NIDEK AFC-230 · image size 848x848:
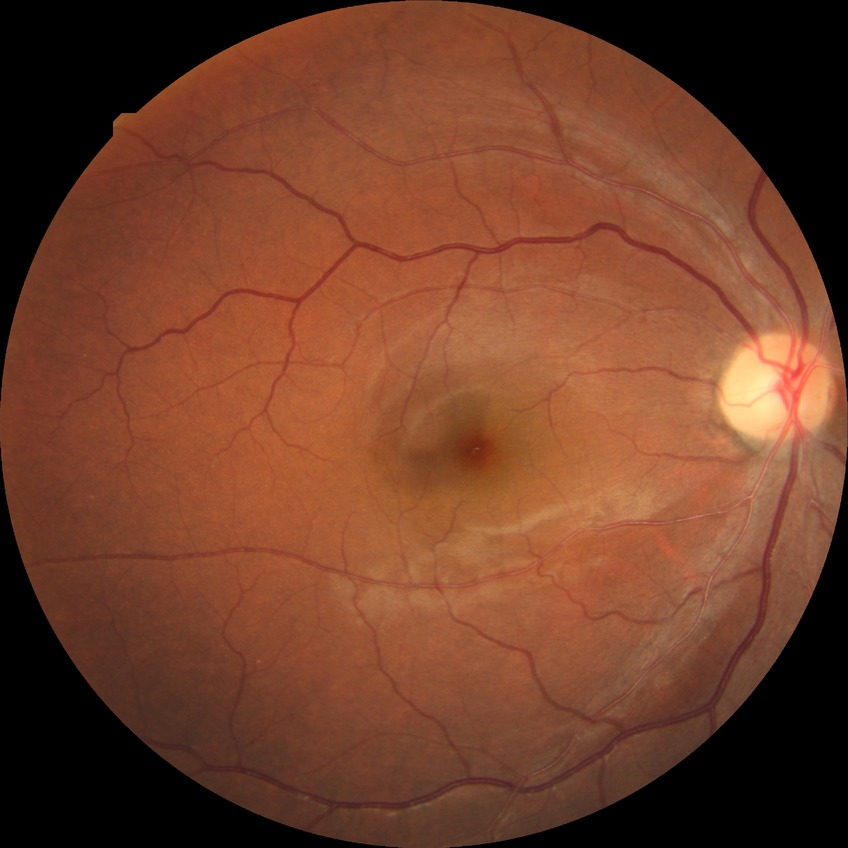

modified Davis classification=simple diabetic retinopathy.